Nonmydriatic fundus photograph · modified Davis grading
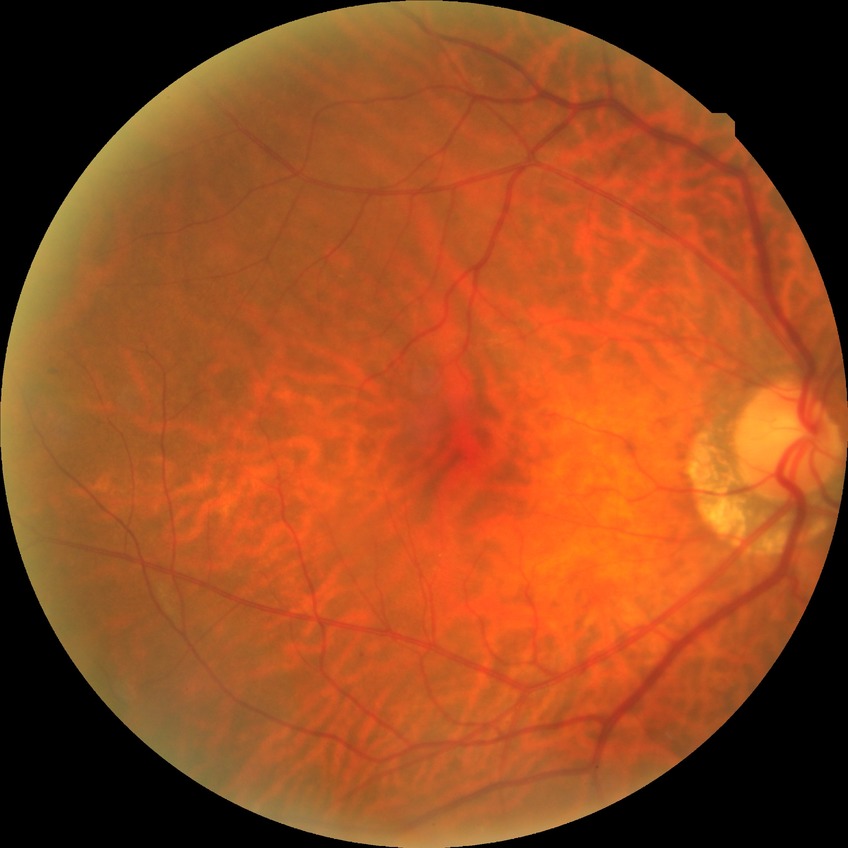 Diabetic retinopathy (DR): NDR (no diabetic retinopathy).